Infant wide-field retinal image · Clarity RetCam 3, 130° FOV.
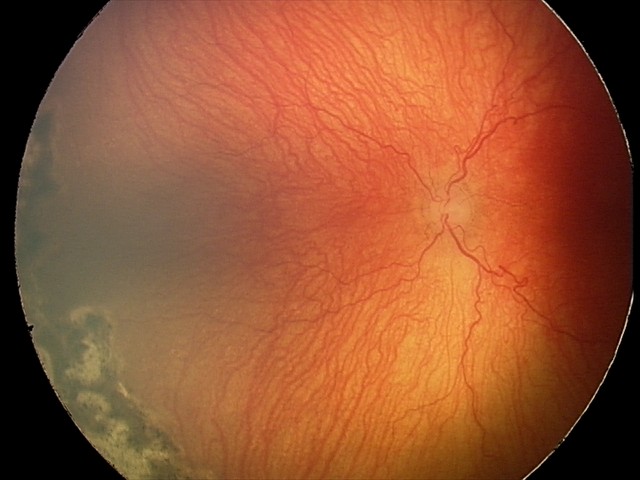 Series diagnosed as aggressive retinopathy of prematurity — rapidly progressive severe ROP with prominent plus disease, often without classic stage progression.